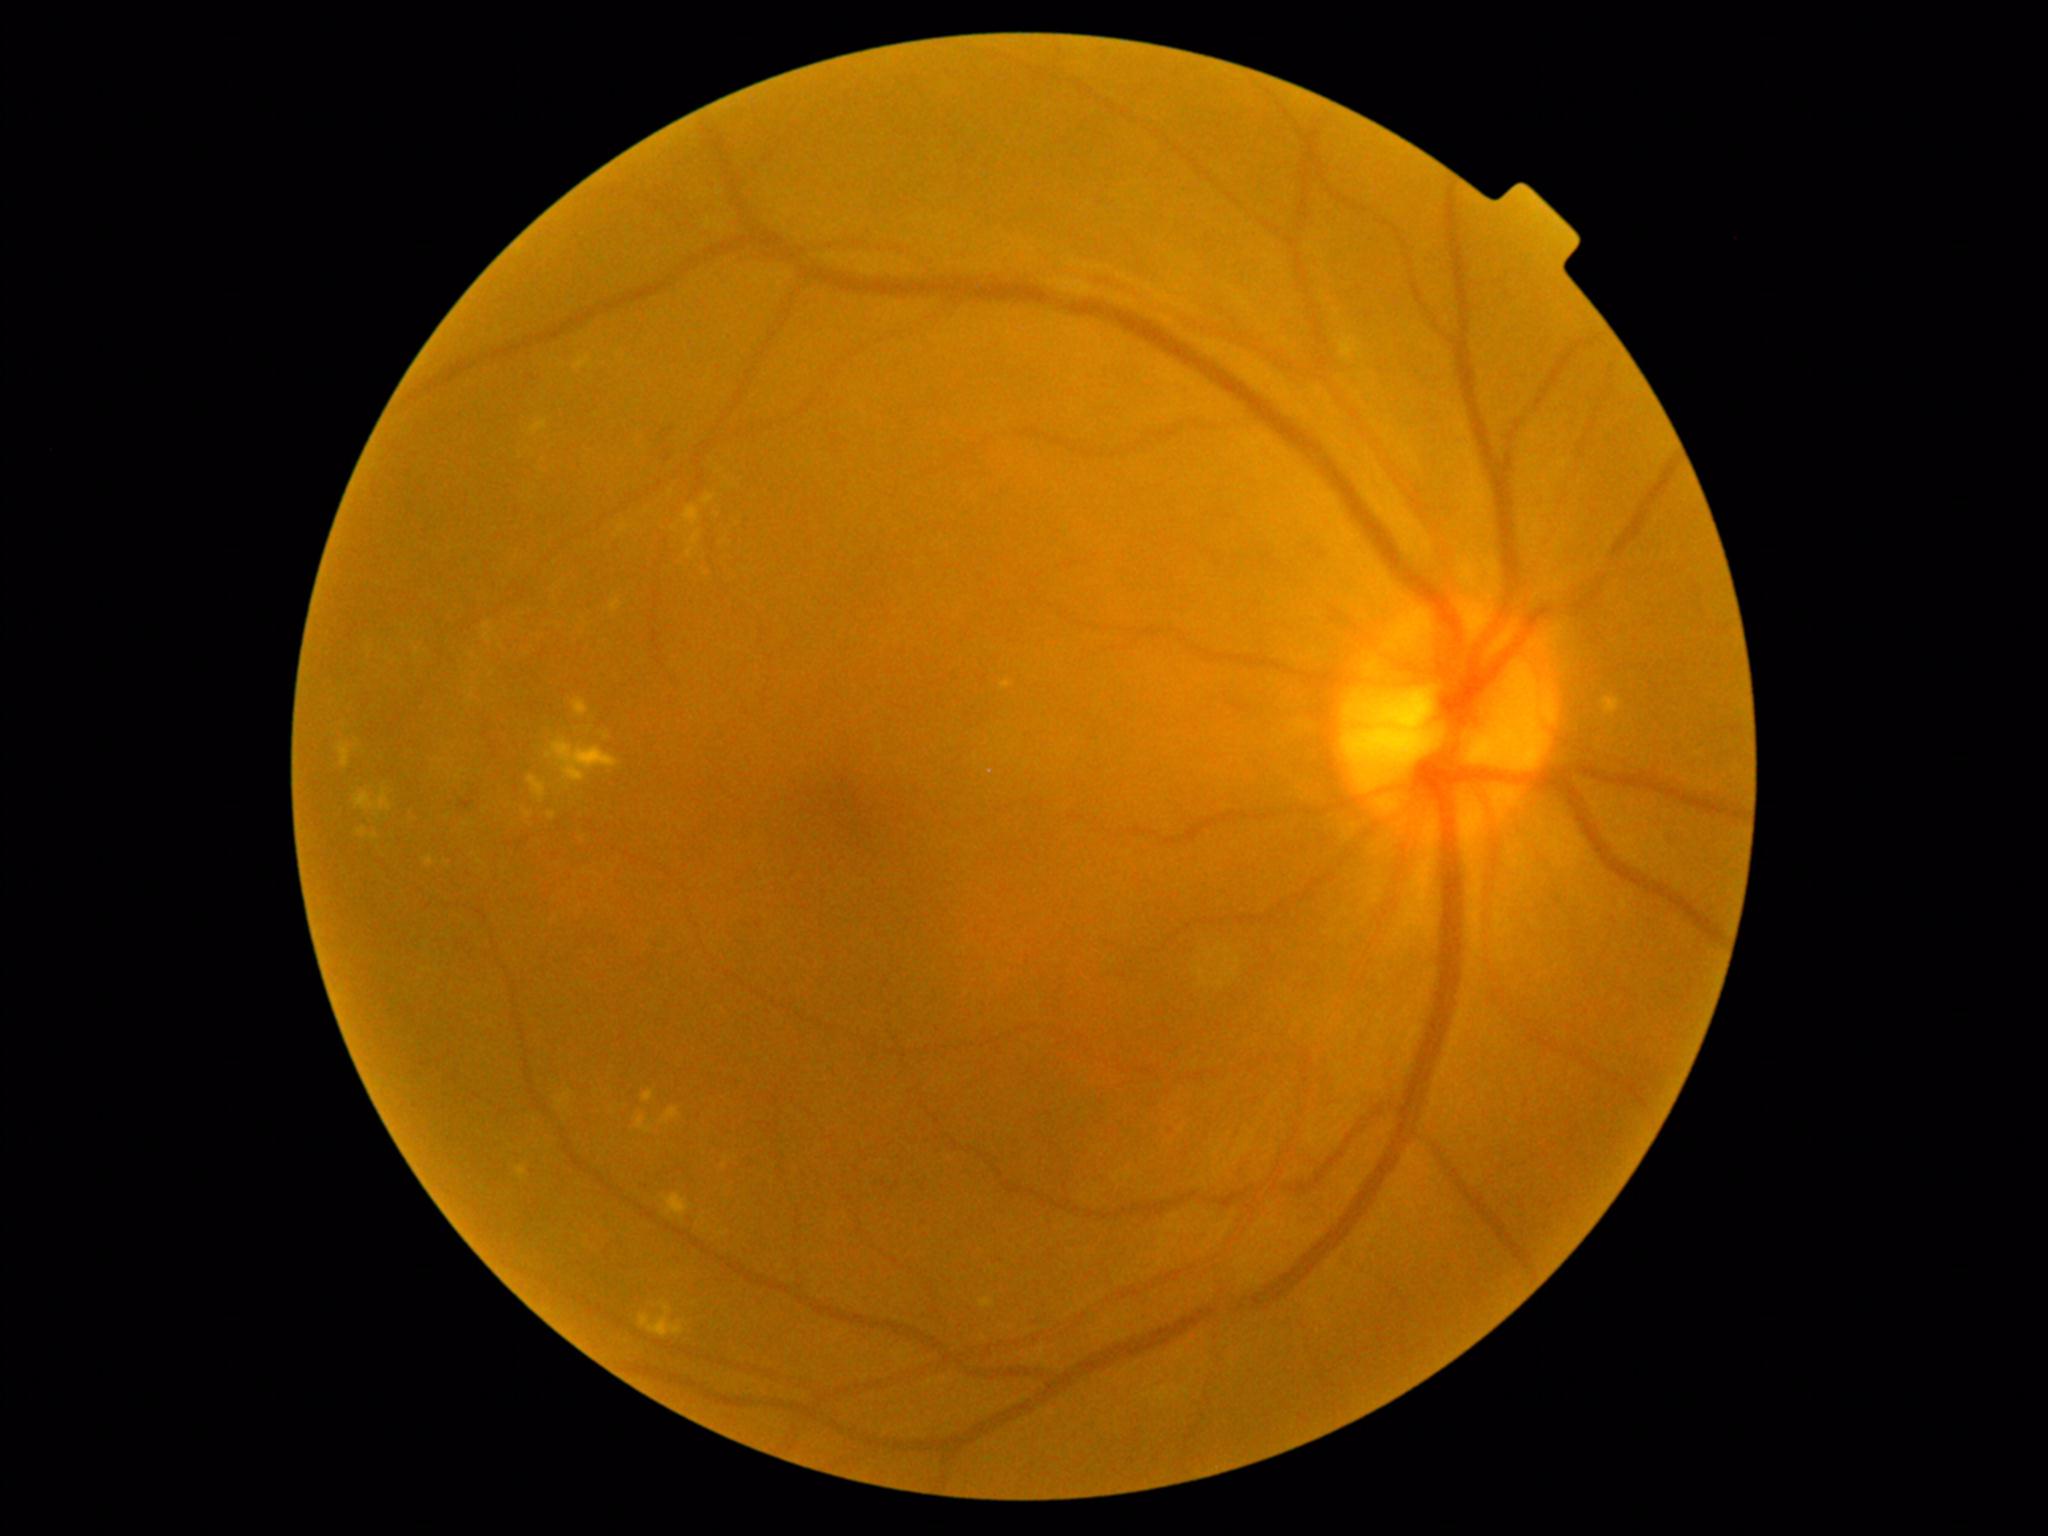

{"partial":true,"dr_grade":2,"lesions":{"ex":[[357,827,368,836],[687,548,694,559],[556,1091,572,1105],[640,1300,686,1338],[1602,698,1621,716],[691,532,701,545],[664,1193,691,1216],[548,813,556,820],[340,743,351,768],[574,356,594,370],[701,495,716,505],[635,1114,653,1134],[611,599,622,612]],"ex_small":[[606,737],[582,838],[378,816]]}}